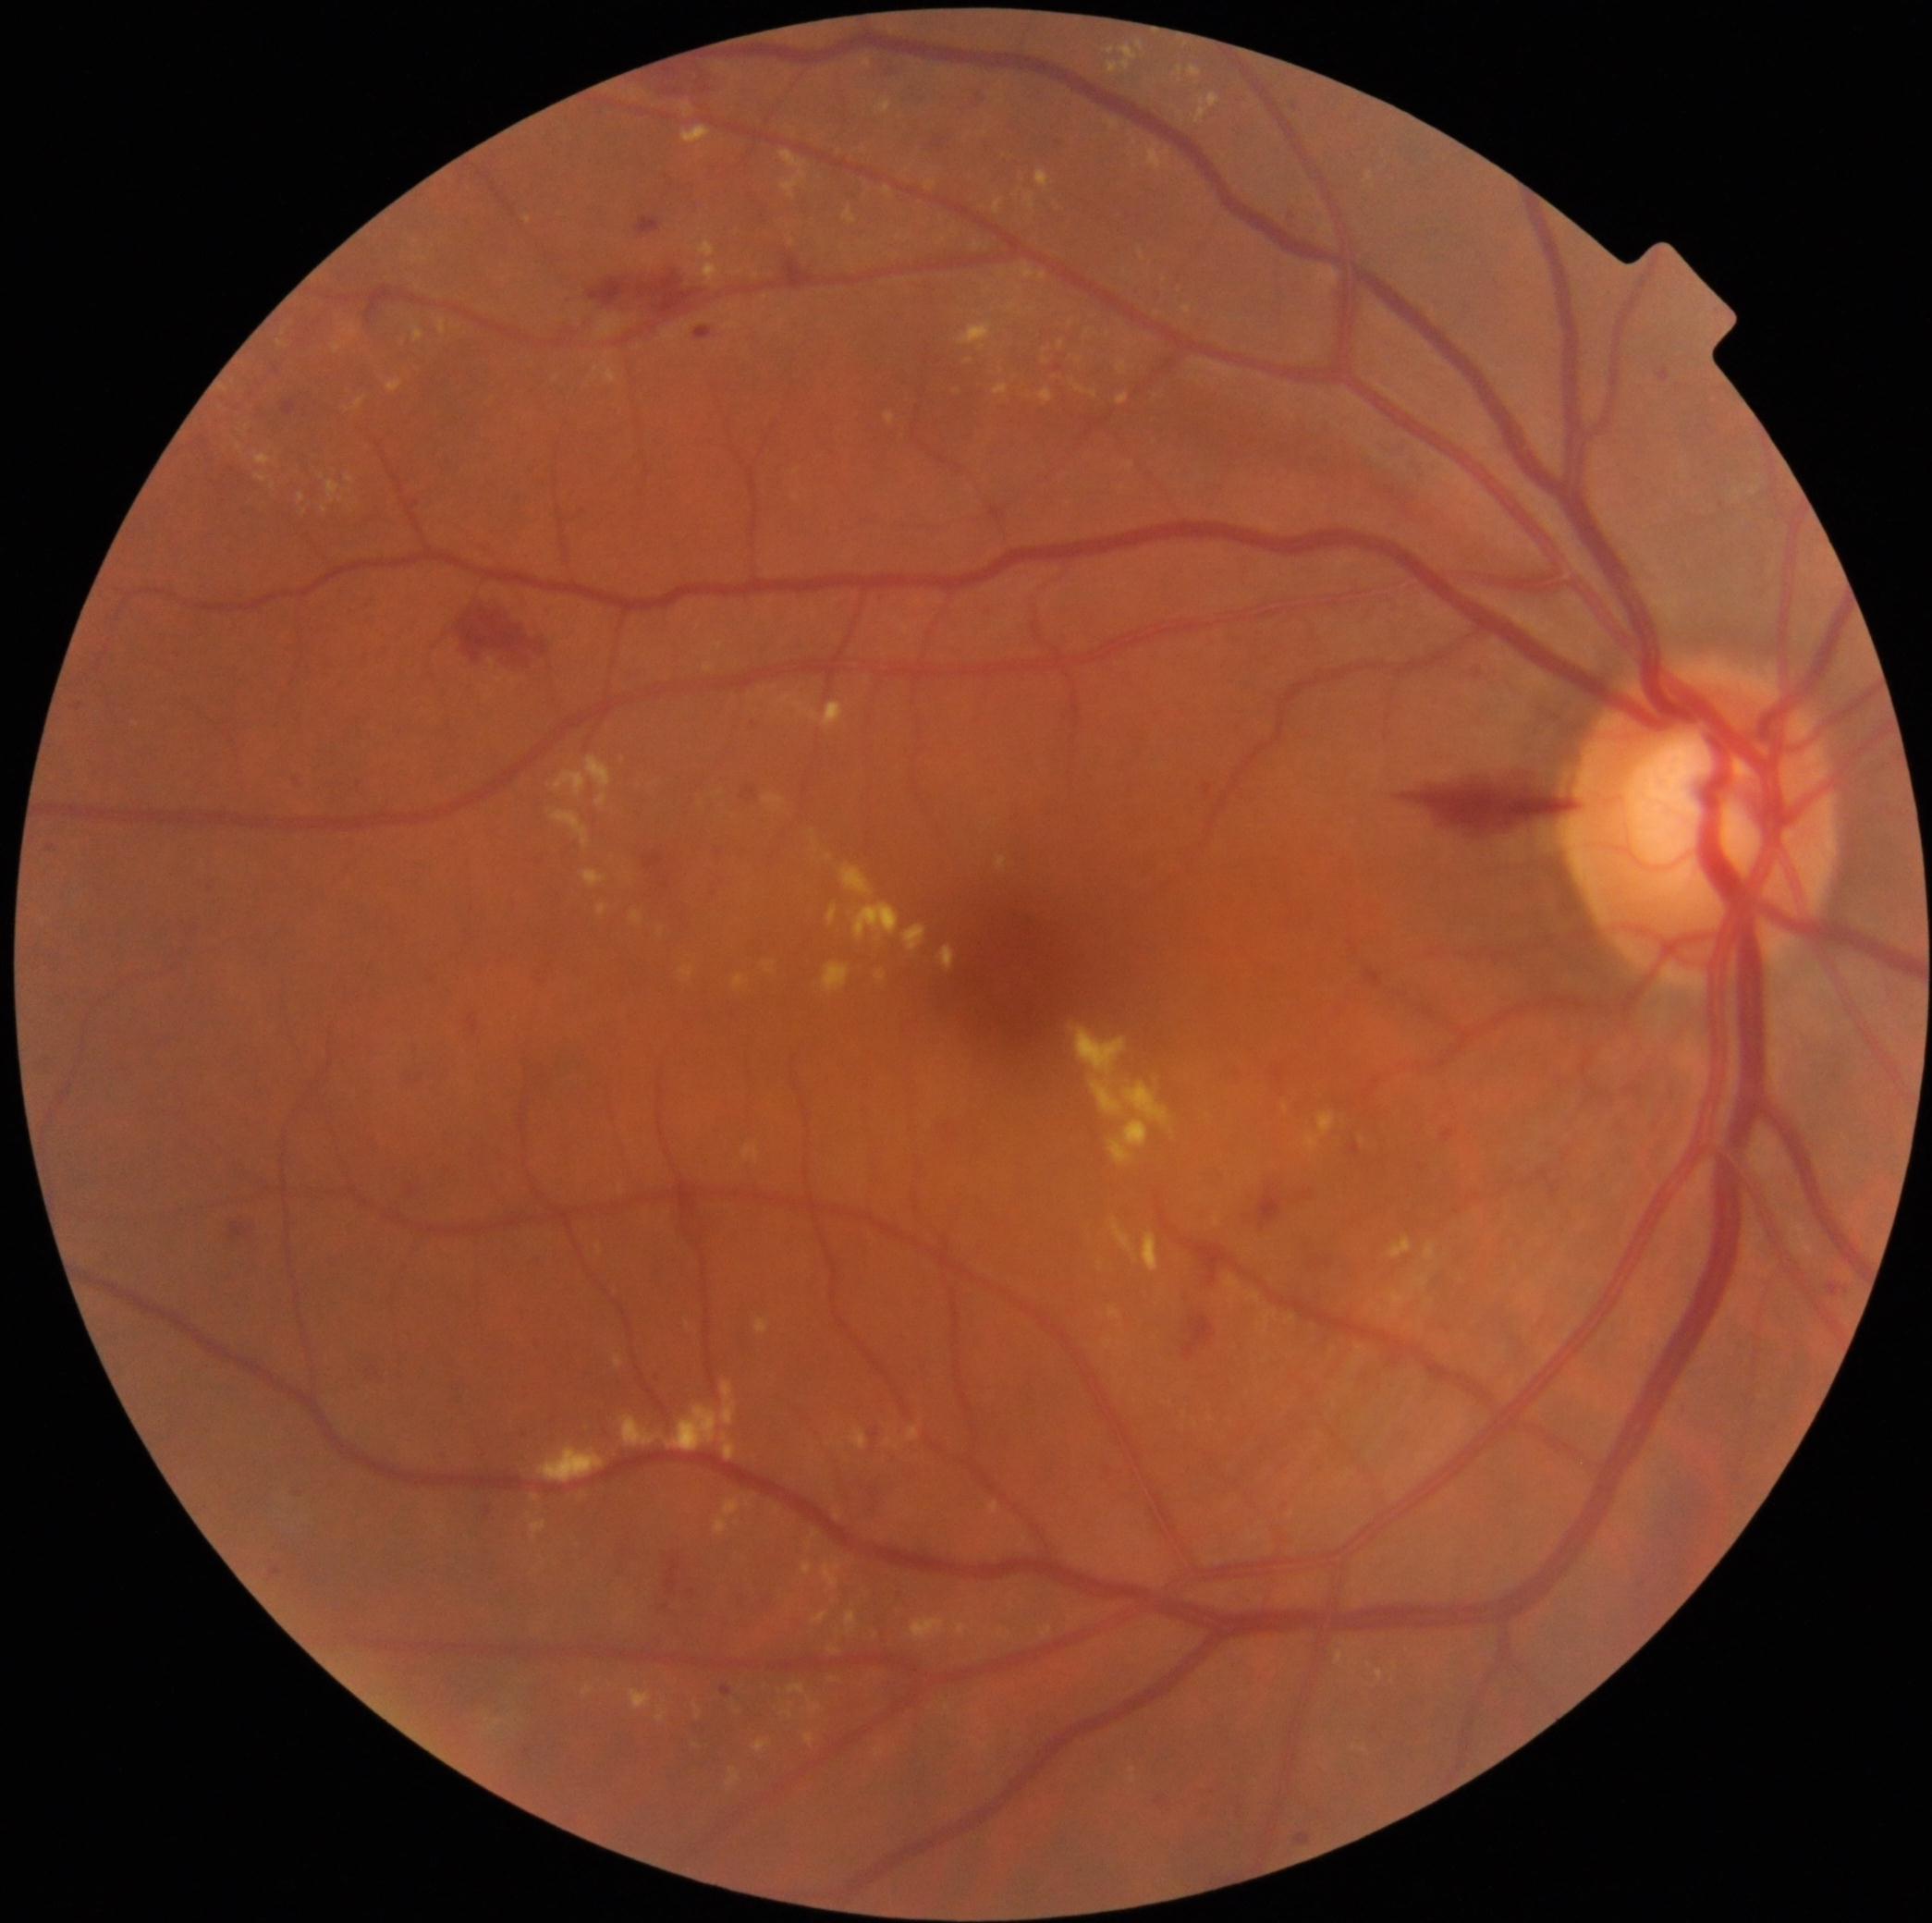

DR grade: 2; non-proliferative diabetic retinopathy
A subset of detected lesions:
EXs (subset) = {"left": 346, "top": 474, "right": 355, "bottom": 484}; {"left": 353, "top": 396, "right": 368, "bottom": 410}; {"left": 990, "top": 1501, "right": 999, "bottom": 1513}; {"left": 698, "top": 237, "right": 716, "bottom": 259}; {"left": 823, "top": 962, "right": 851, "bottom": 993}; {"left": 323, "top": 506, "right": 328, "bottom": 514}; {"left": 753, "top": 1740, "right": 773, "bottom": 1753}; {"left": 1106, "top": 120, "right": 1119, "bottom": 130}; {"left": 1140, "top": 250, "right": 1145, "bottom": 261}; {"left": 413, "top": 326, "right": 424, "bottom": 343}; {"left": 996, "top": 856, "right": 1007, "bottom": 871}; {"left": 552, "top": 811, "right": 591, "bottom": 849}; {"left": 682, "top": 126, "right": 713, "bottom": 145}
Small EXs near {"x": 343, "y": 499}; {"x": 829, "y": 858}; {"x": 417, "y": 261}; {"x": 1370, "y": 1665}; {"x": 1157, "y": 314}; {"x": 535, "y": 1497}